2212x1659 · color fundus image
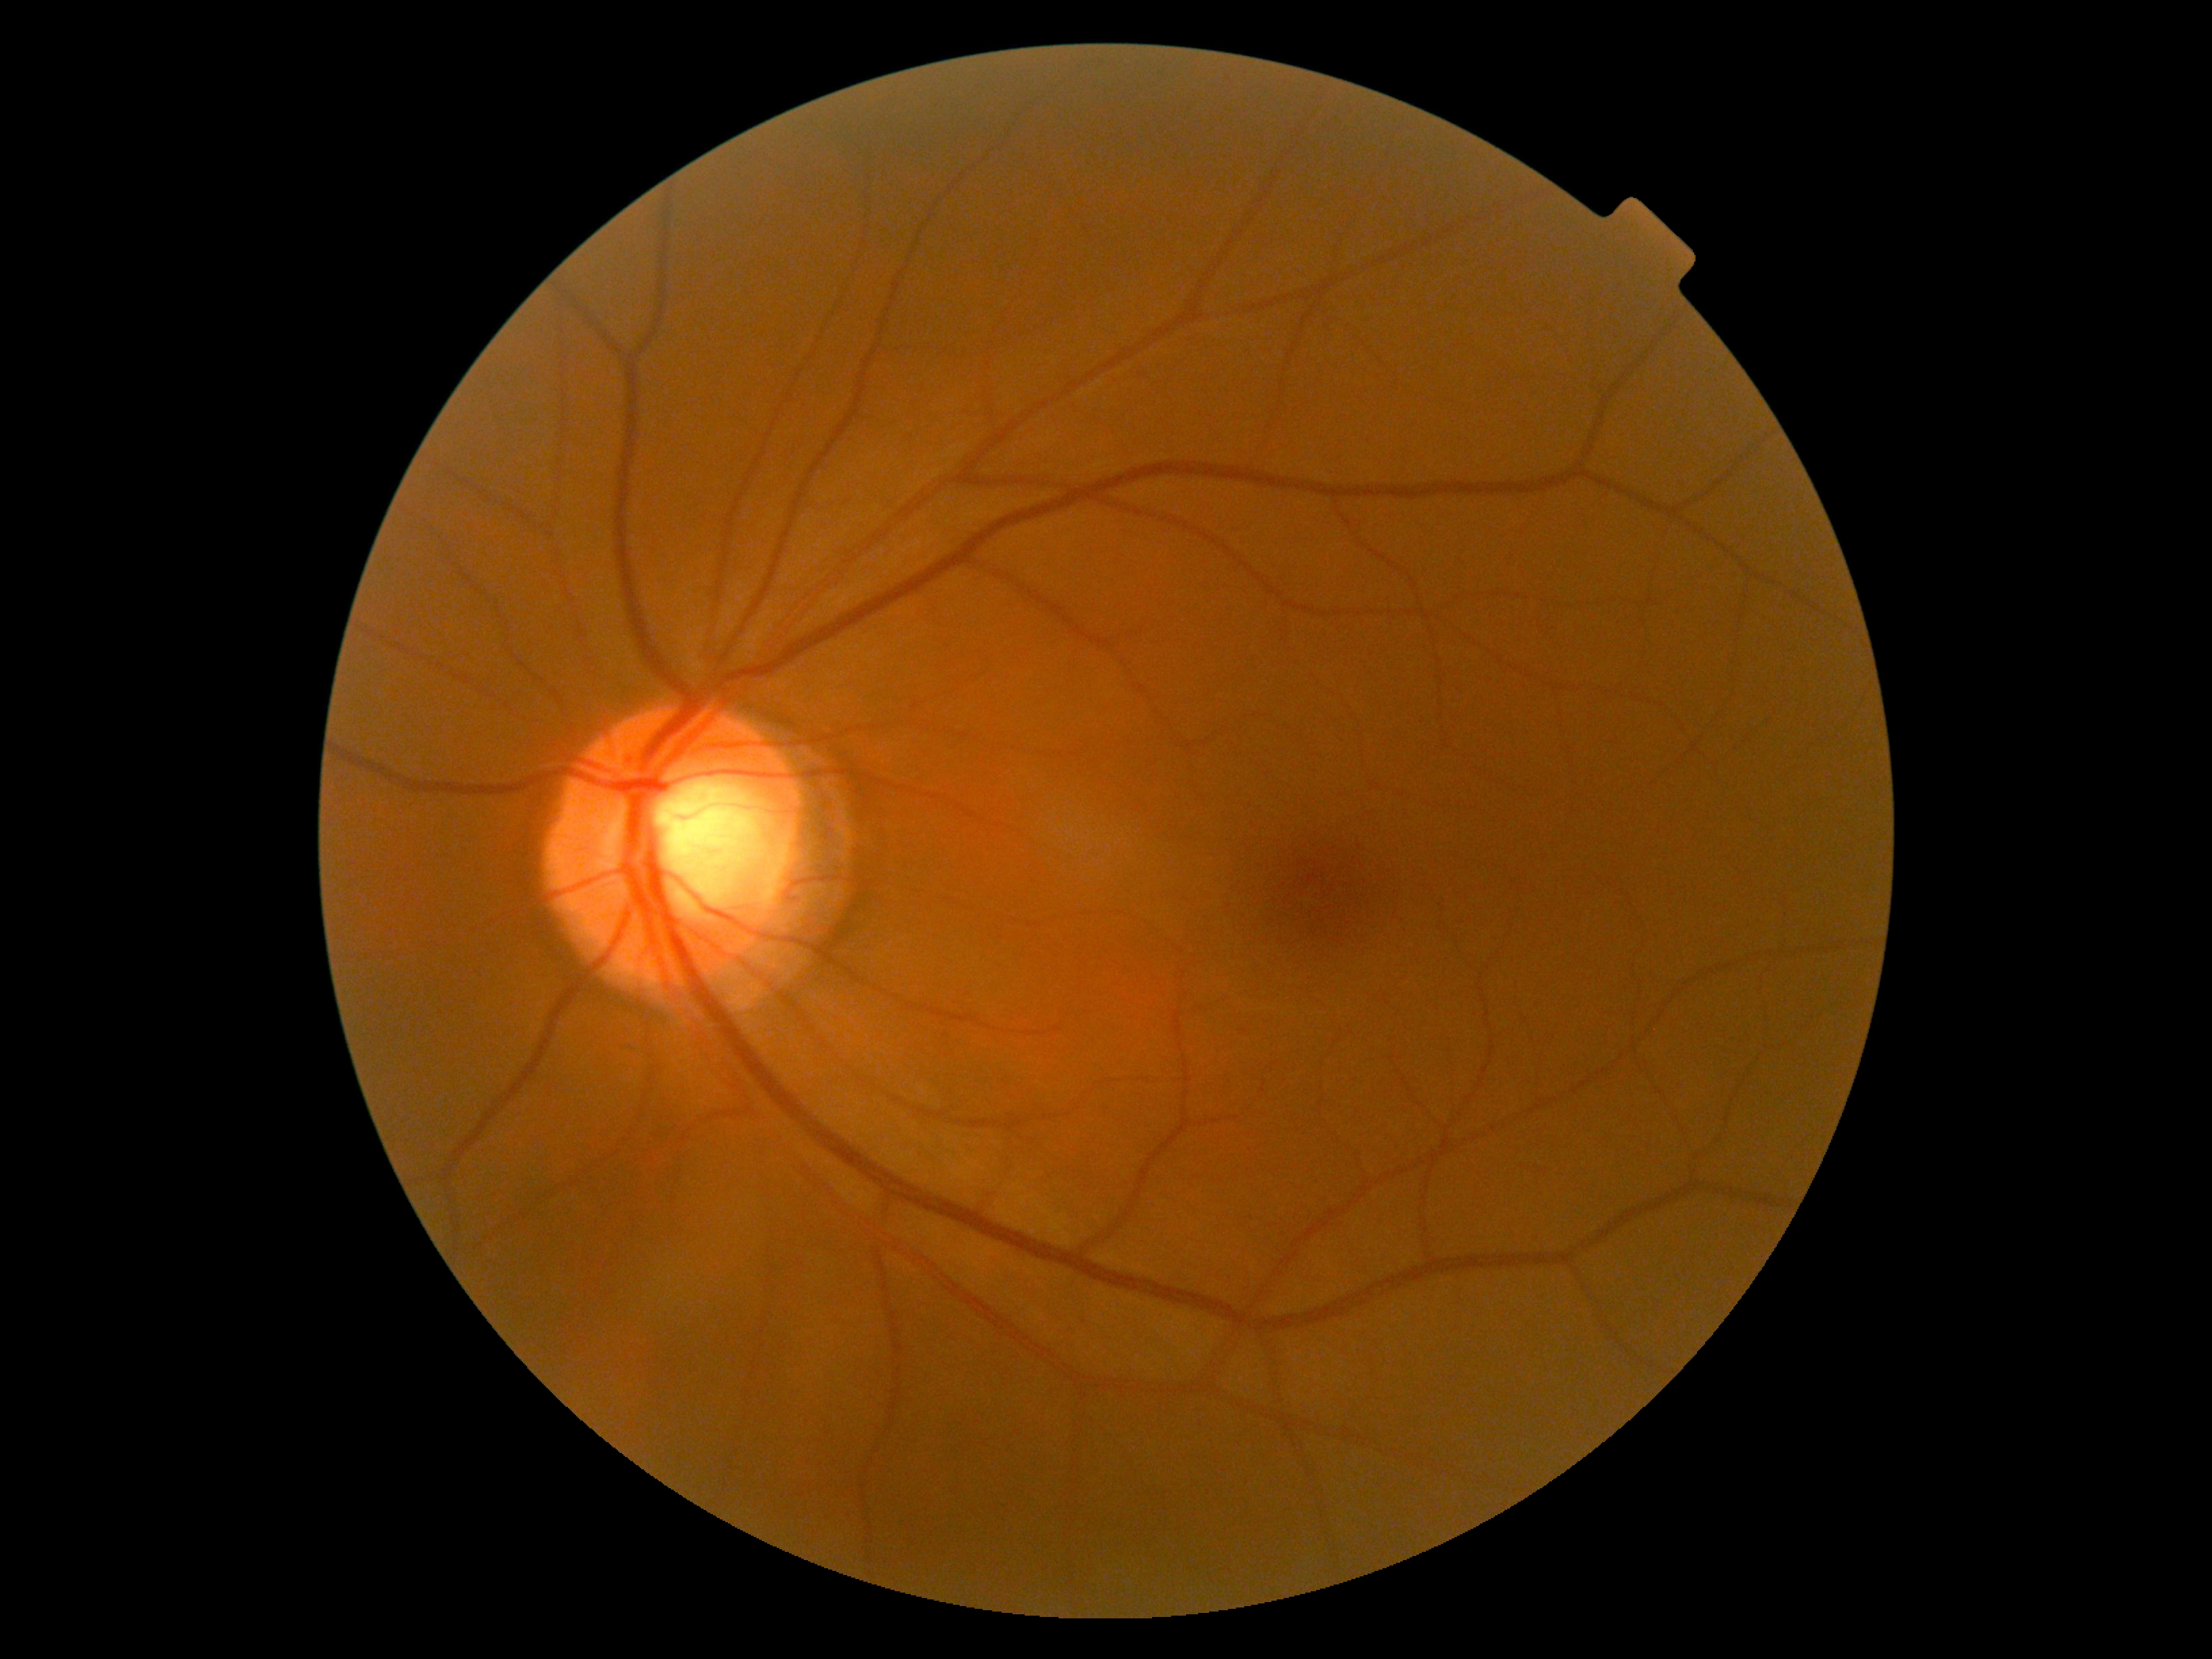 retinopathy = grade 0
DR impression = no signs of DR